2212 by 1659 pixels: 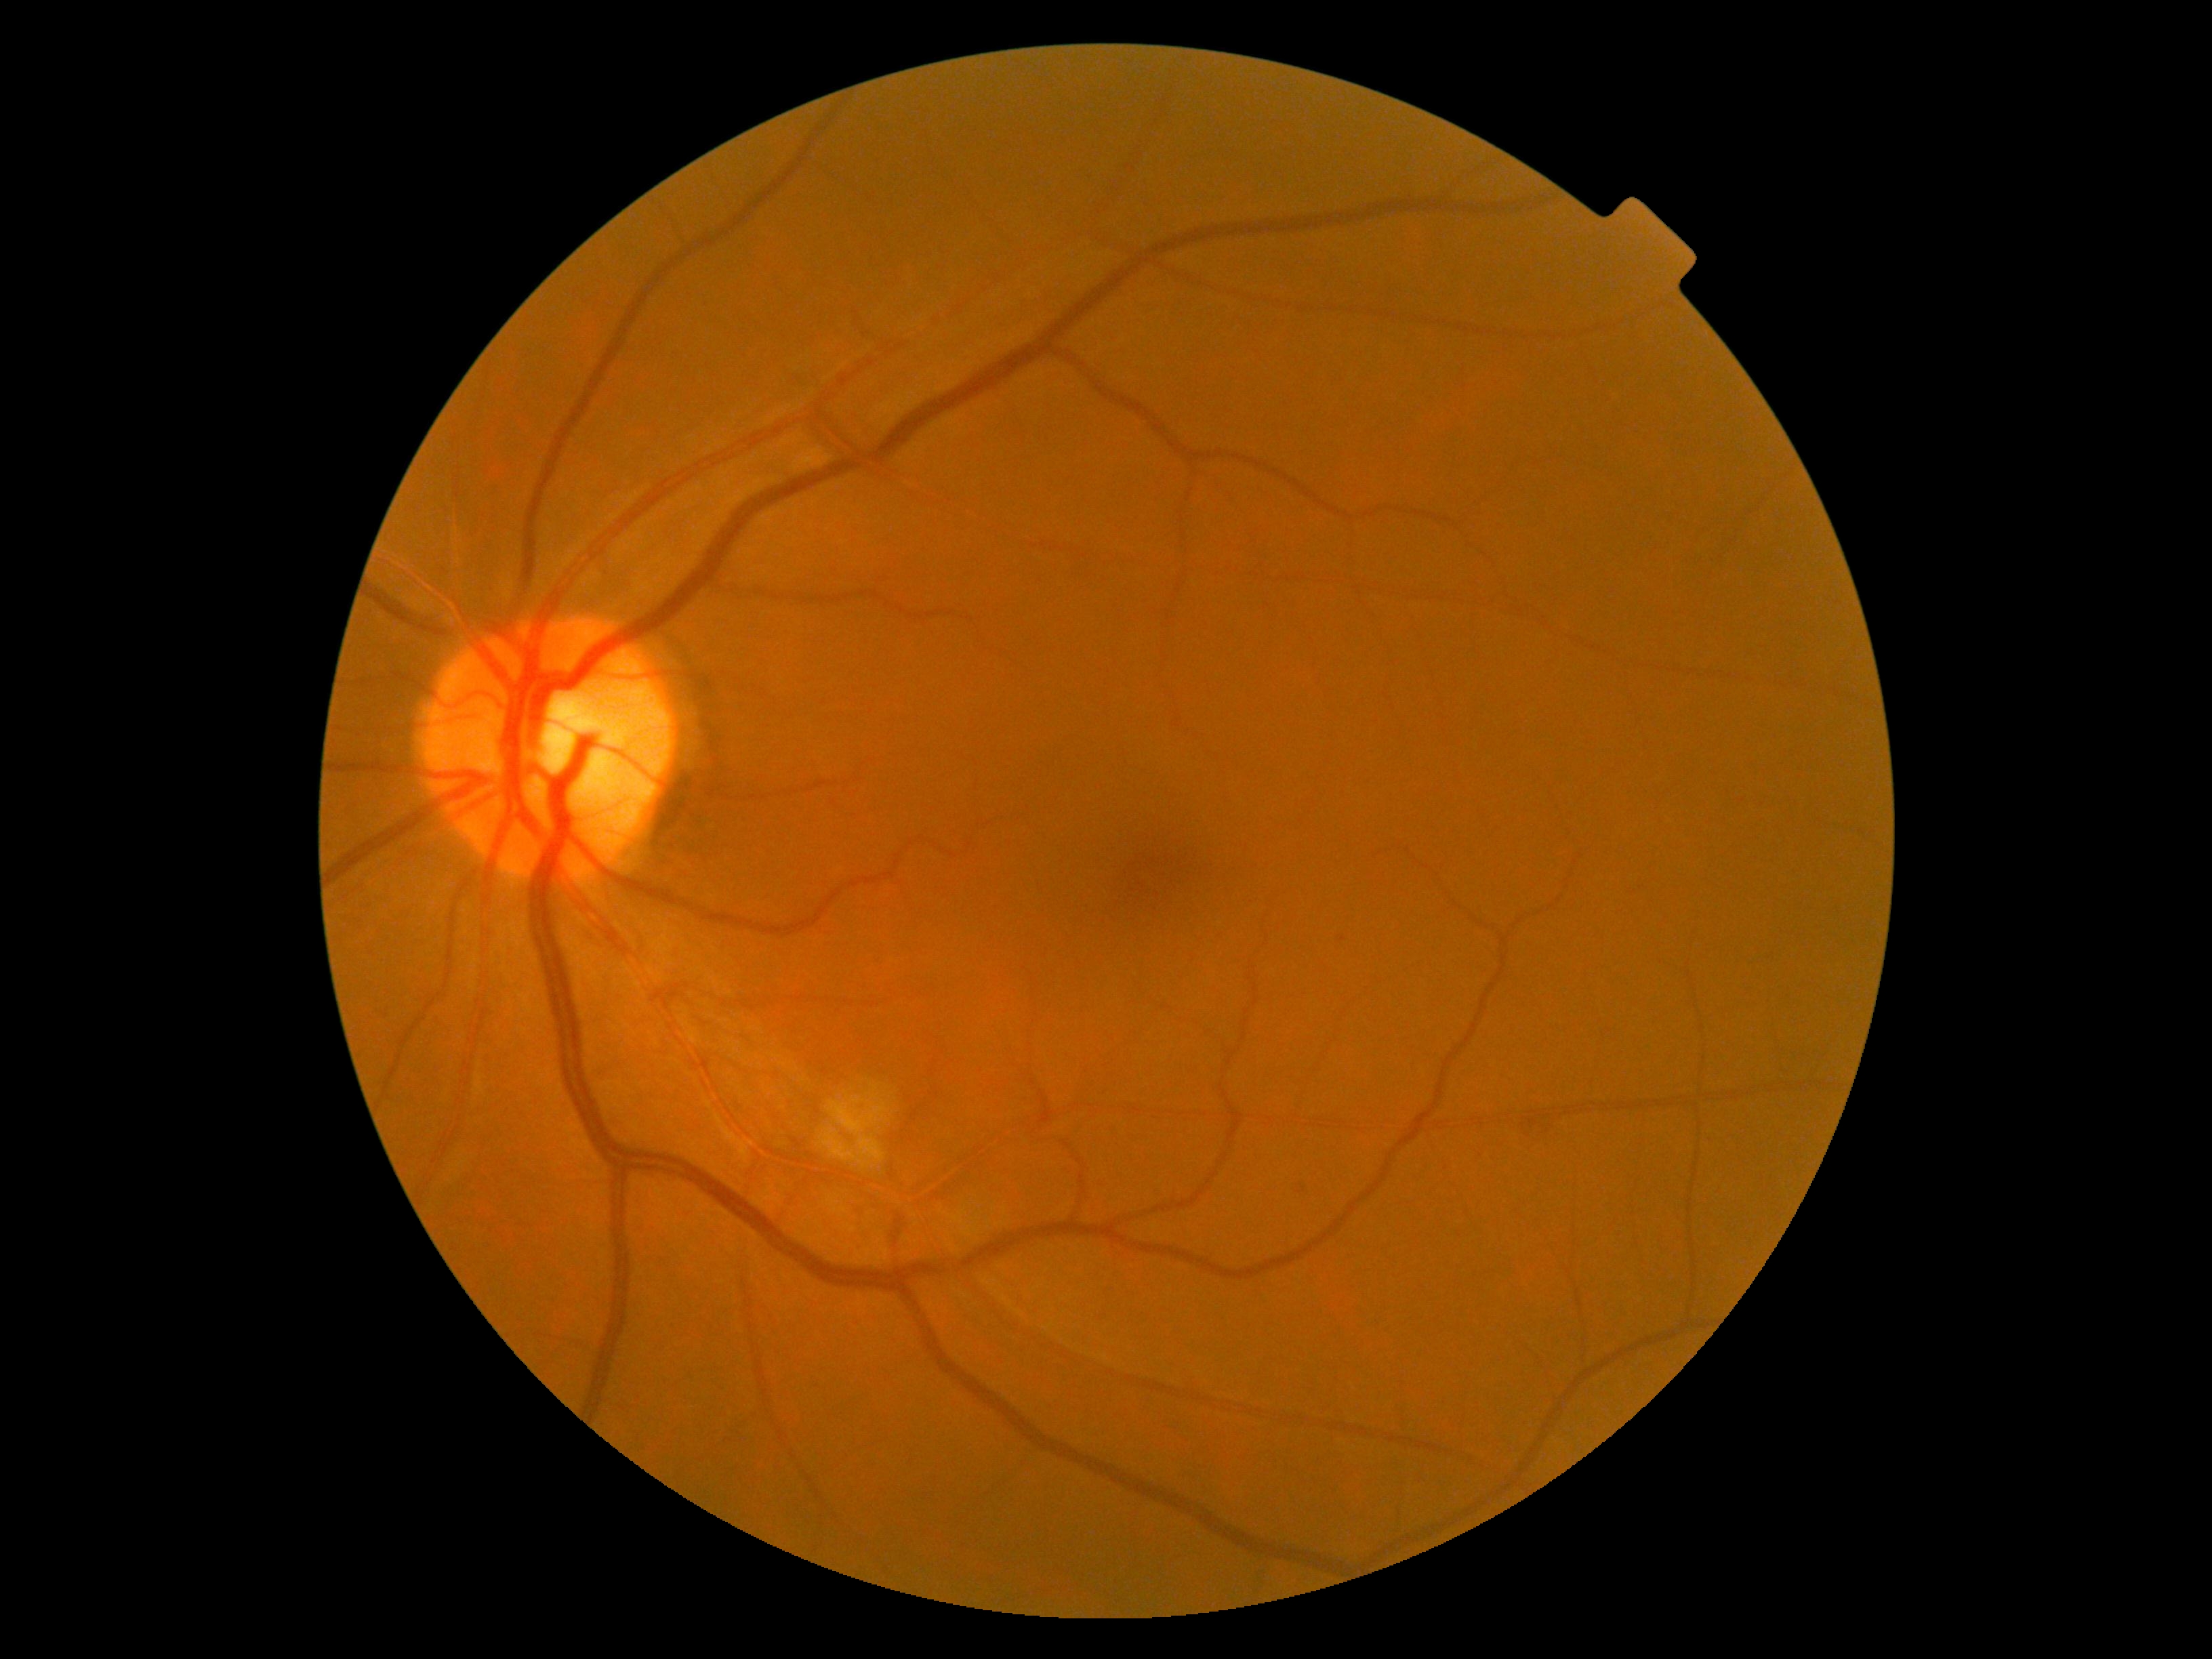

DR stage: grade 2 (moderate NPDR) — more than just microaneurysms but less than severe NPDR.